Color fundus image: 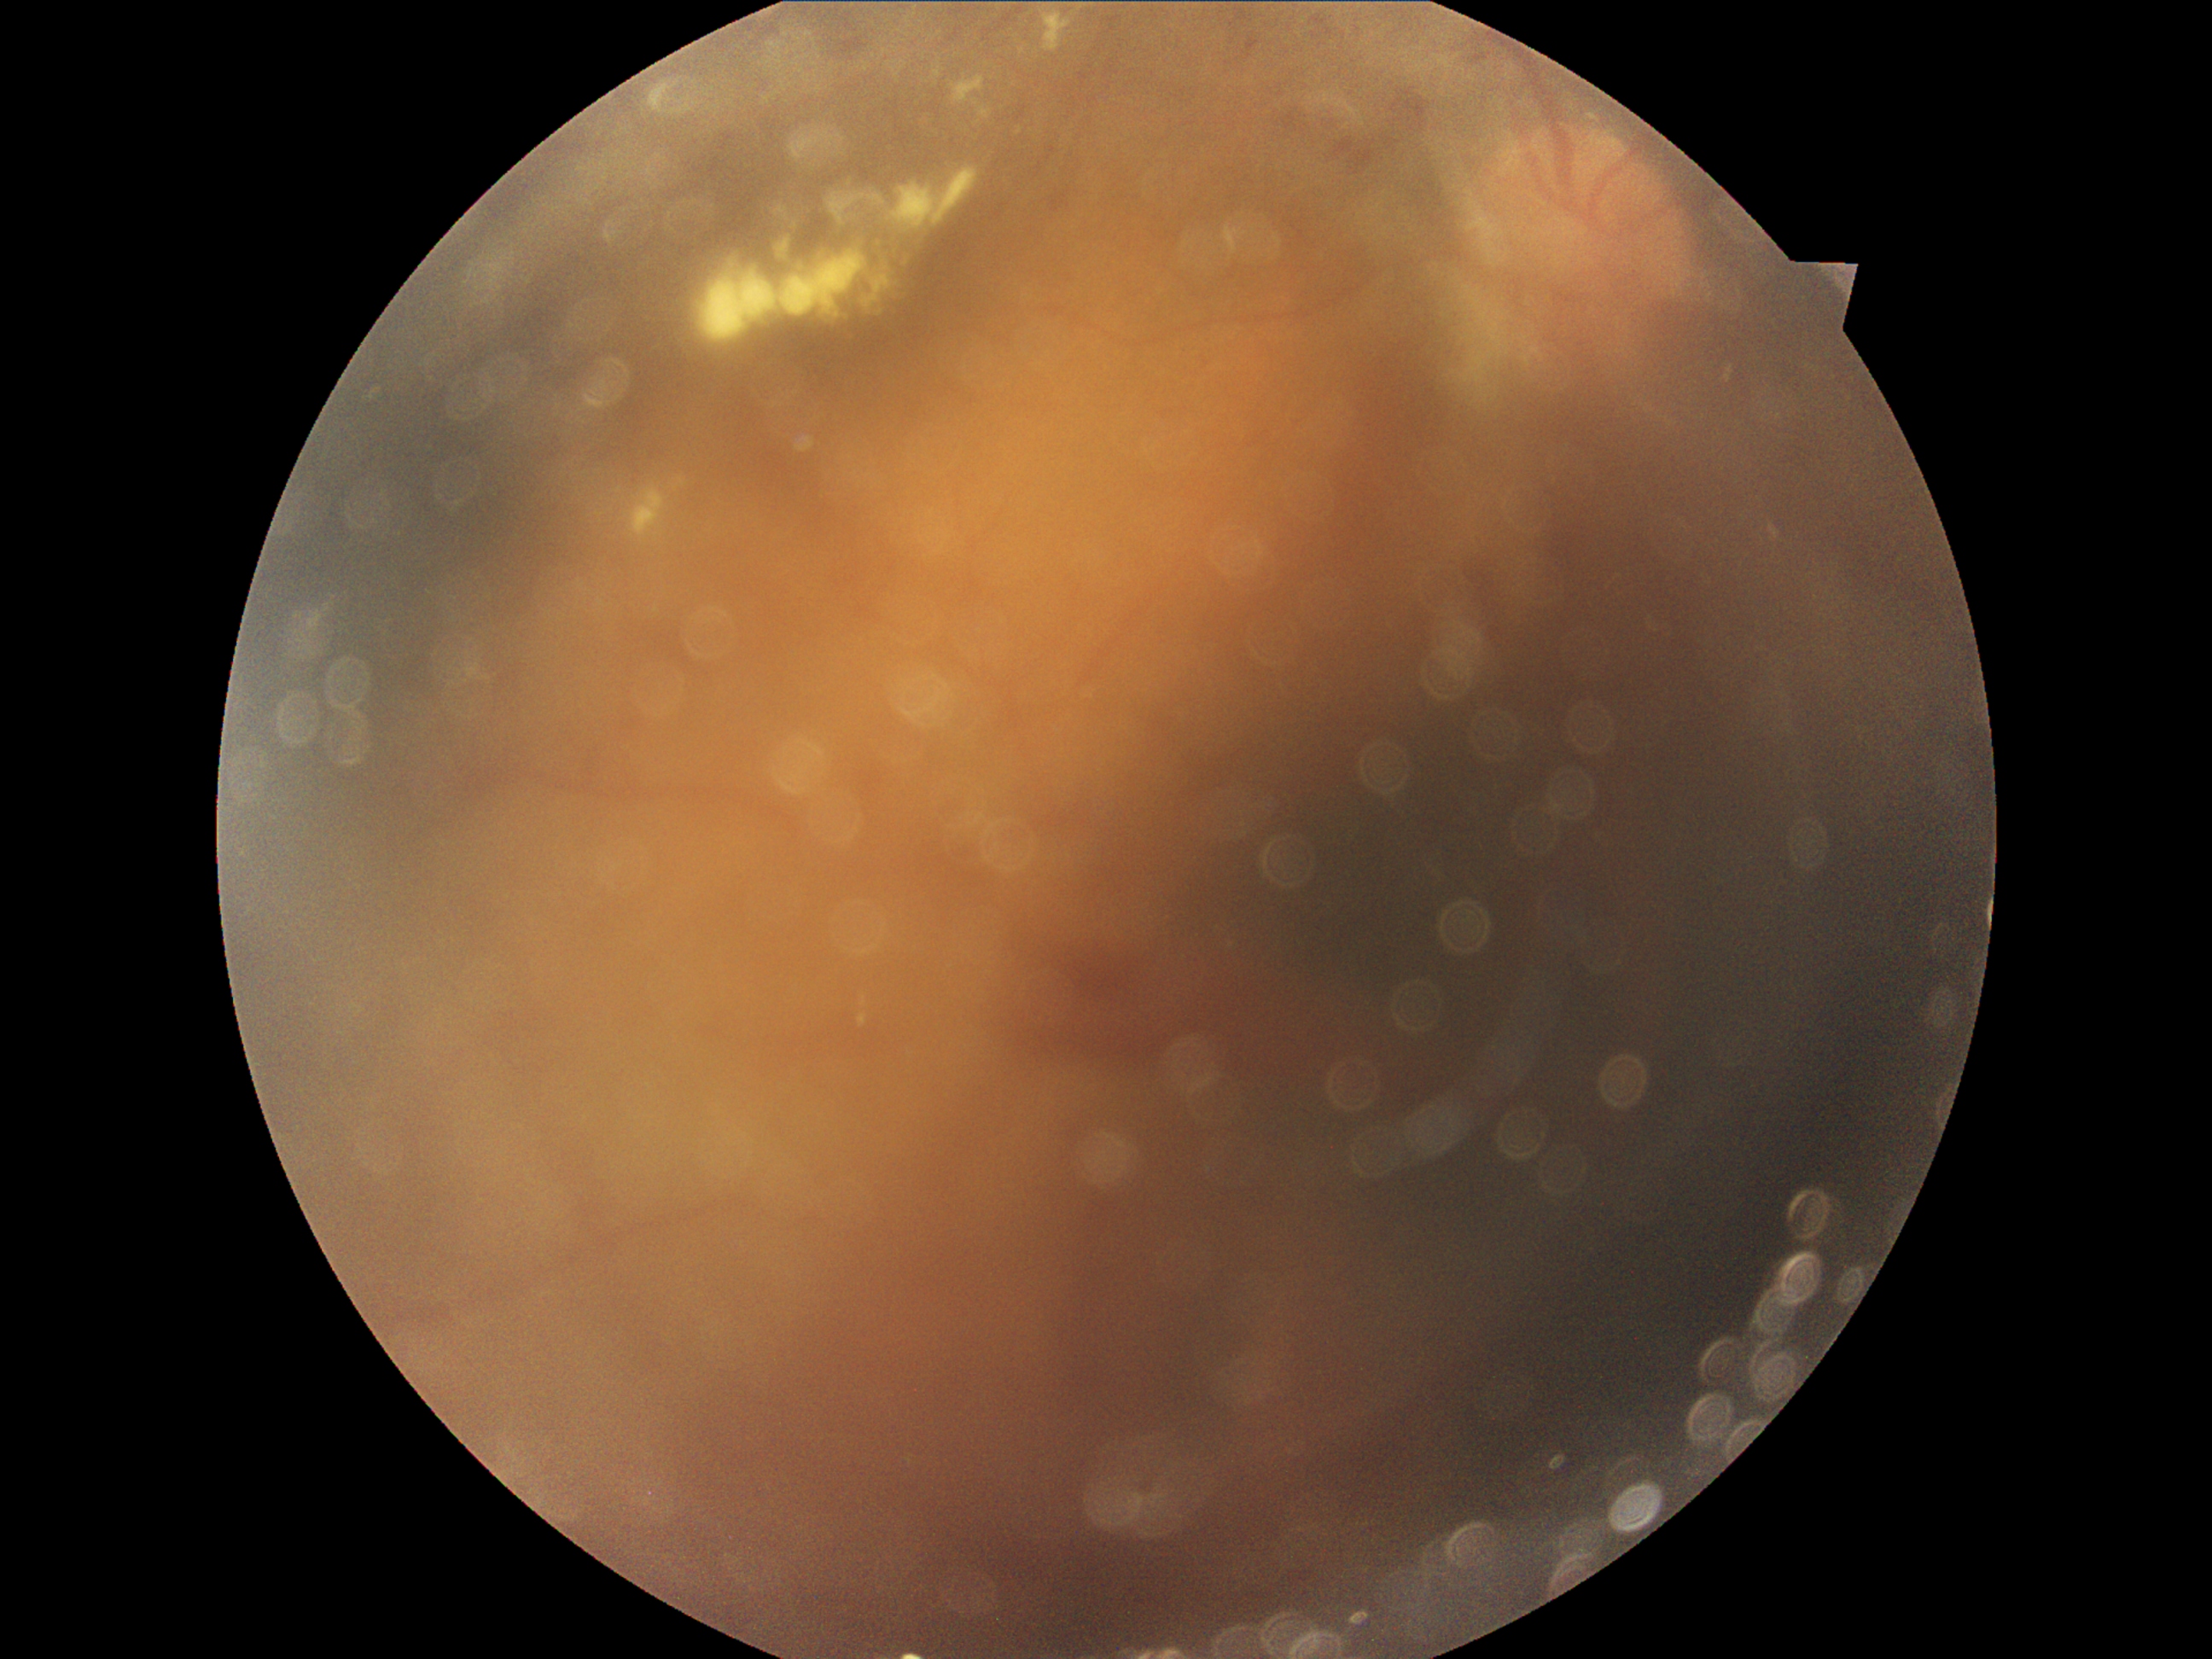
  dr_grade: grade 4